Infant wide-field retinal image.
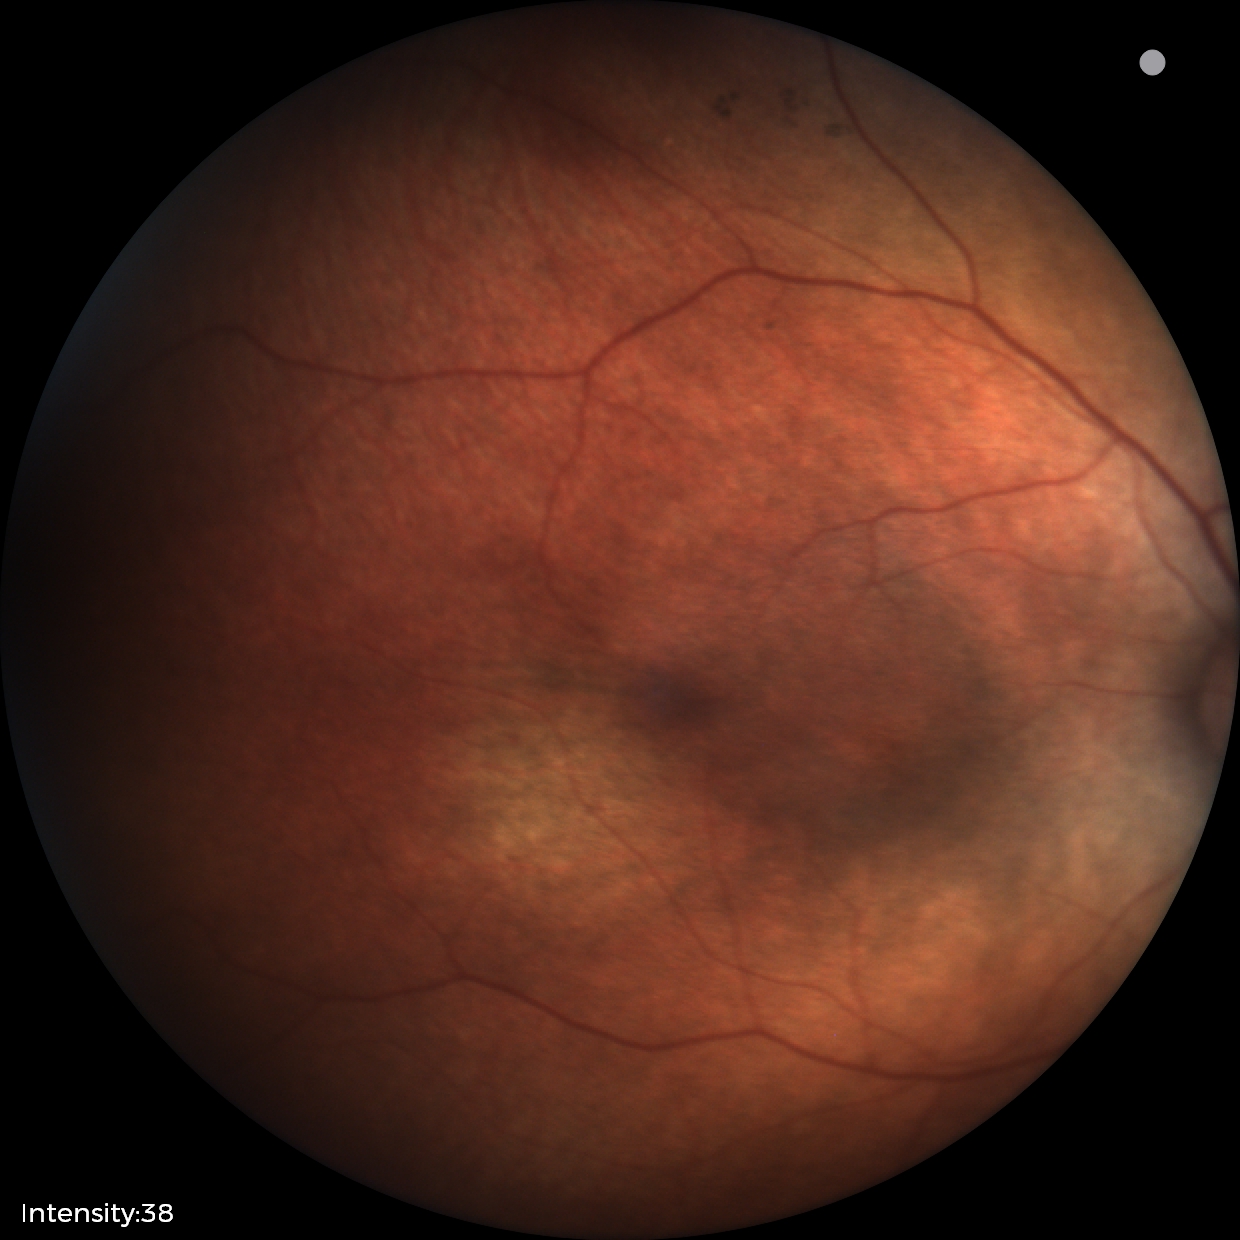
Screening examination diagnosed as physiological.